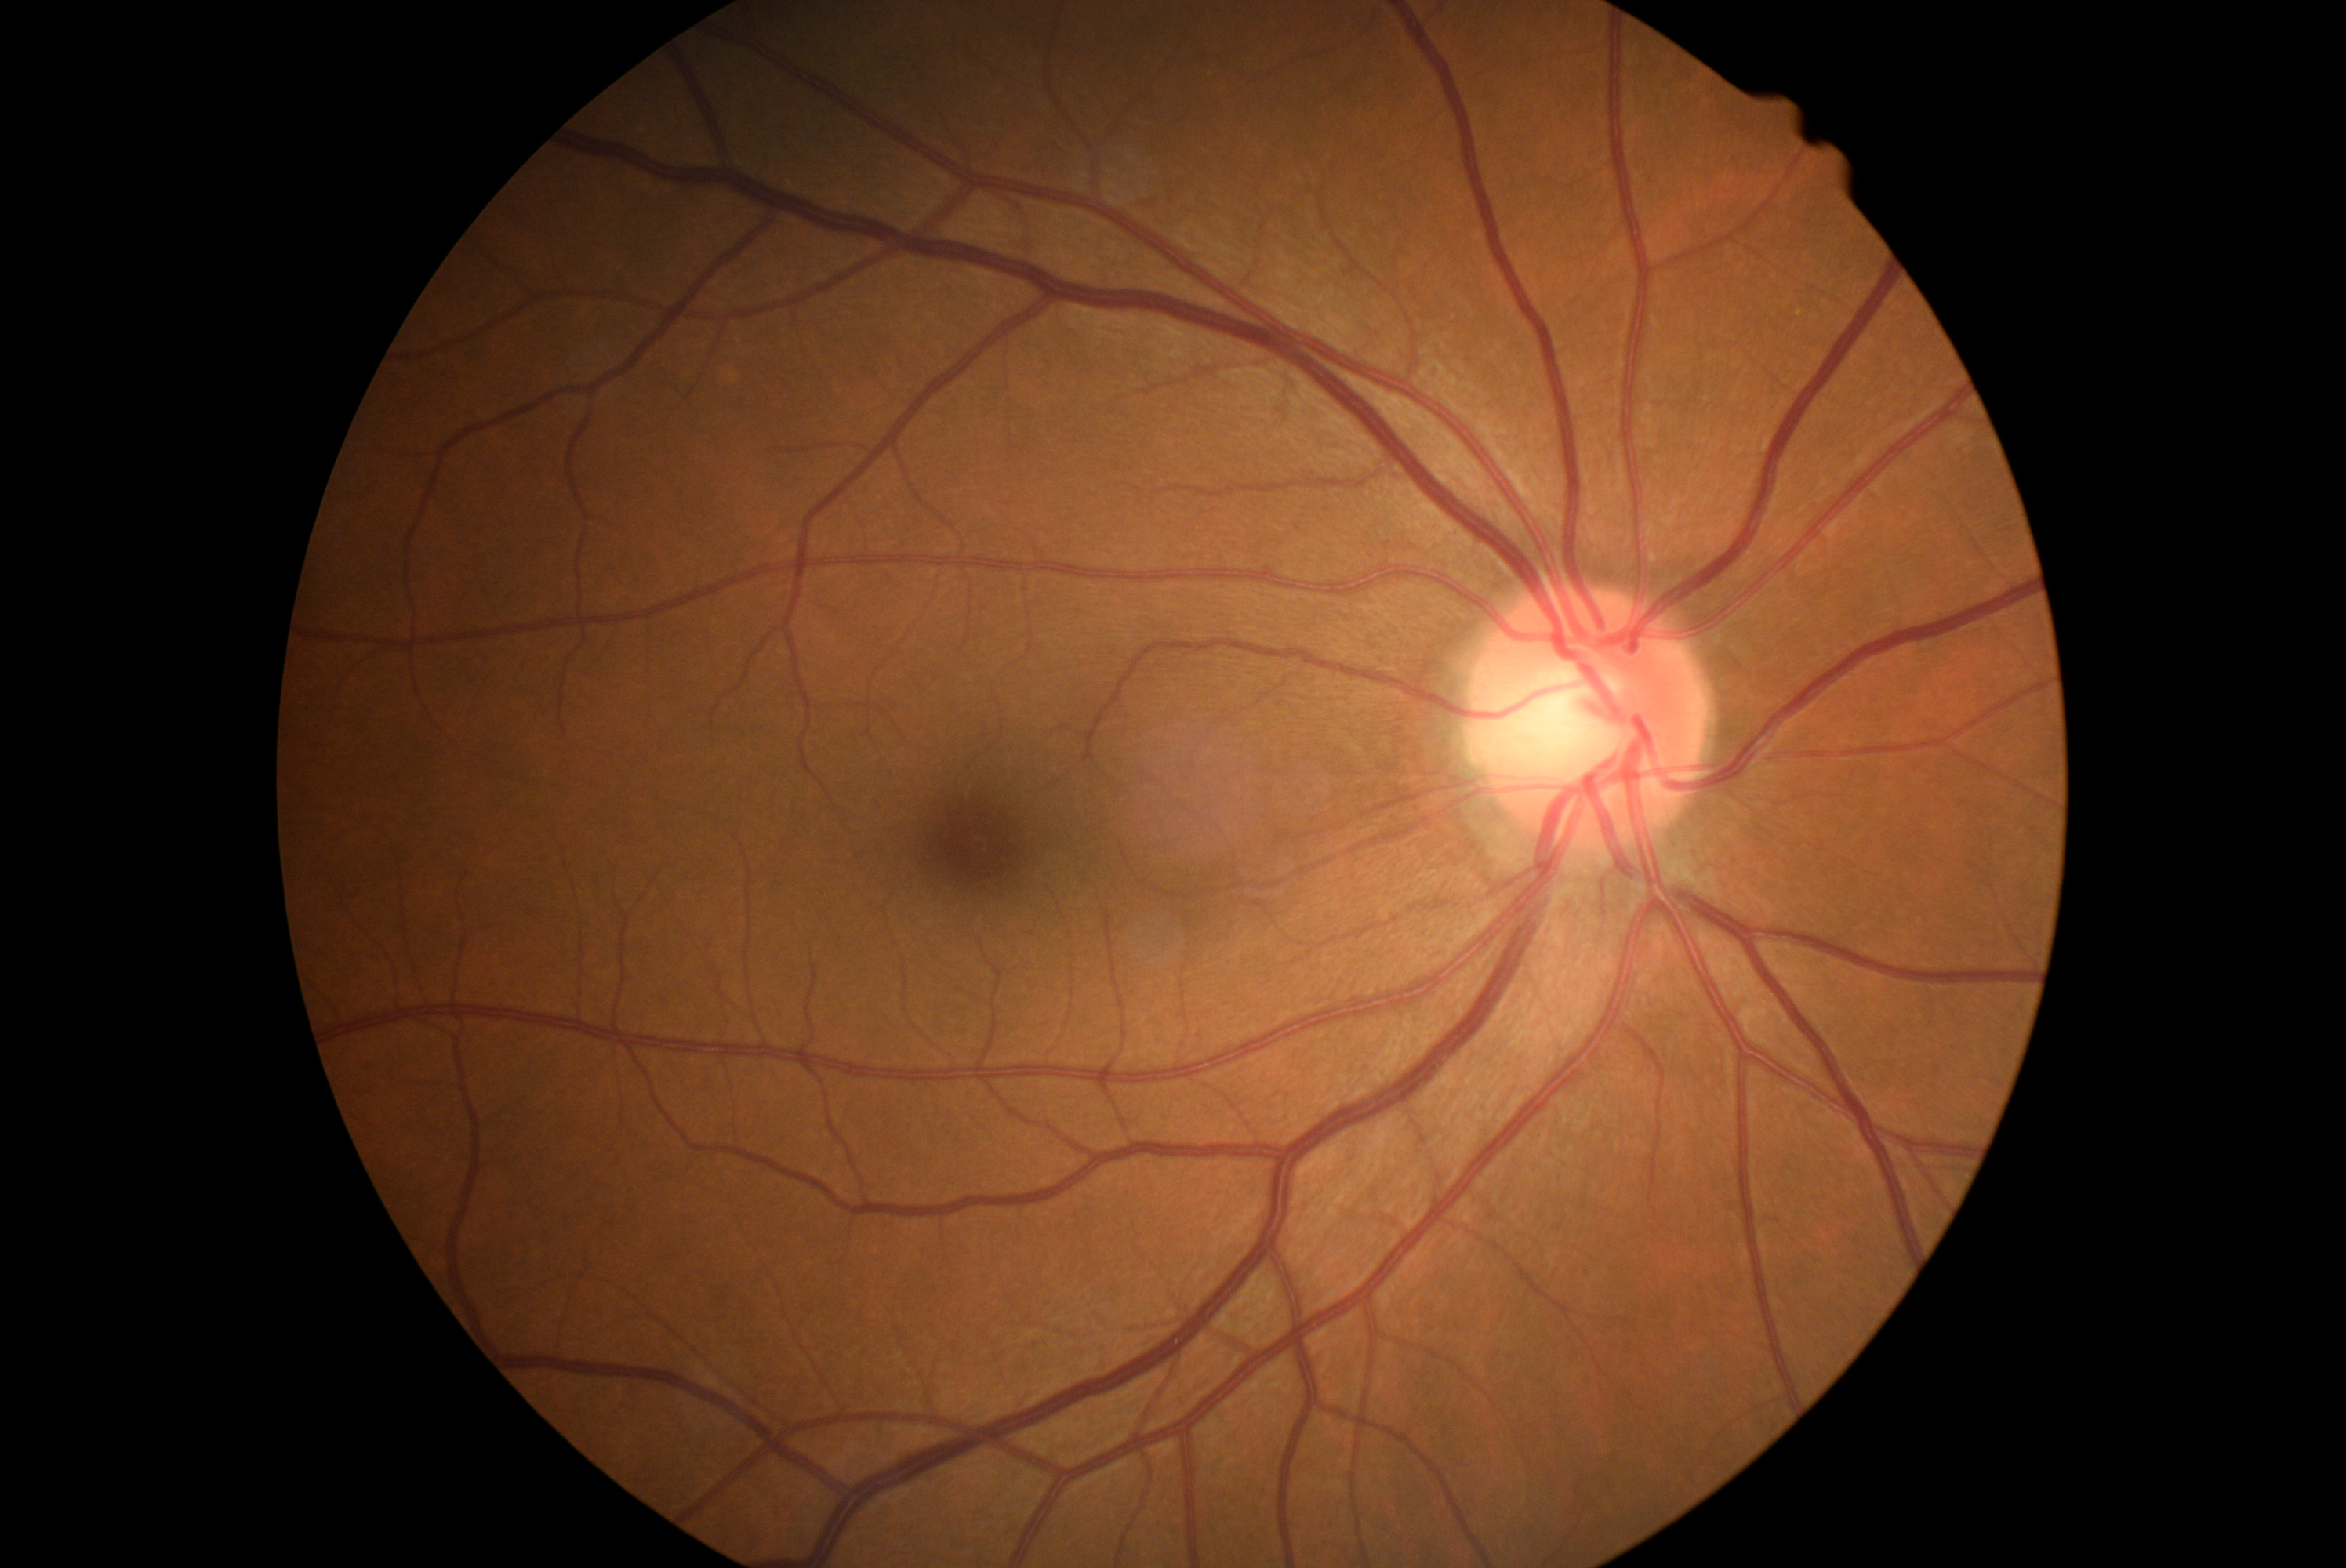

No apparent diabetic retinopathy. DR severity: grade 0.